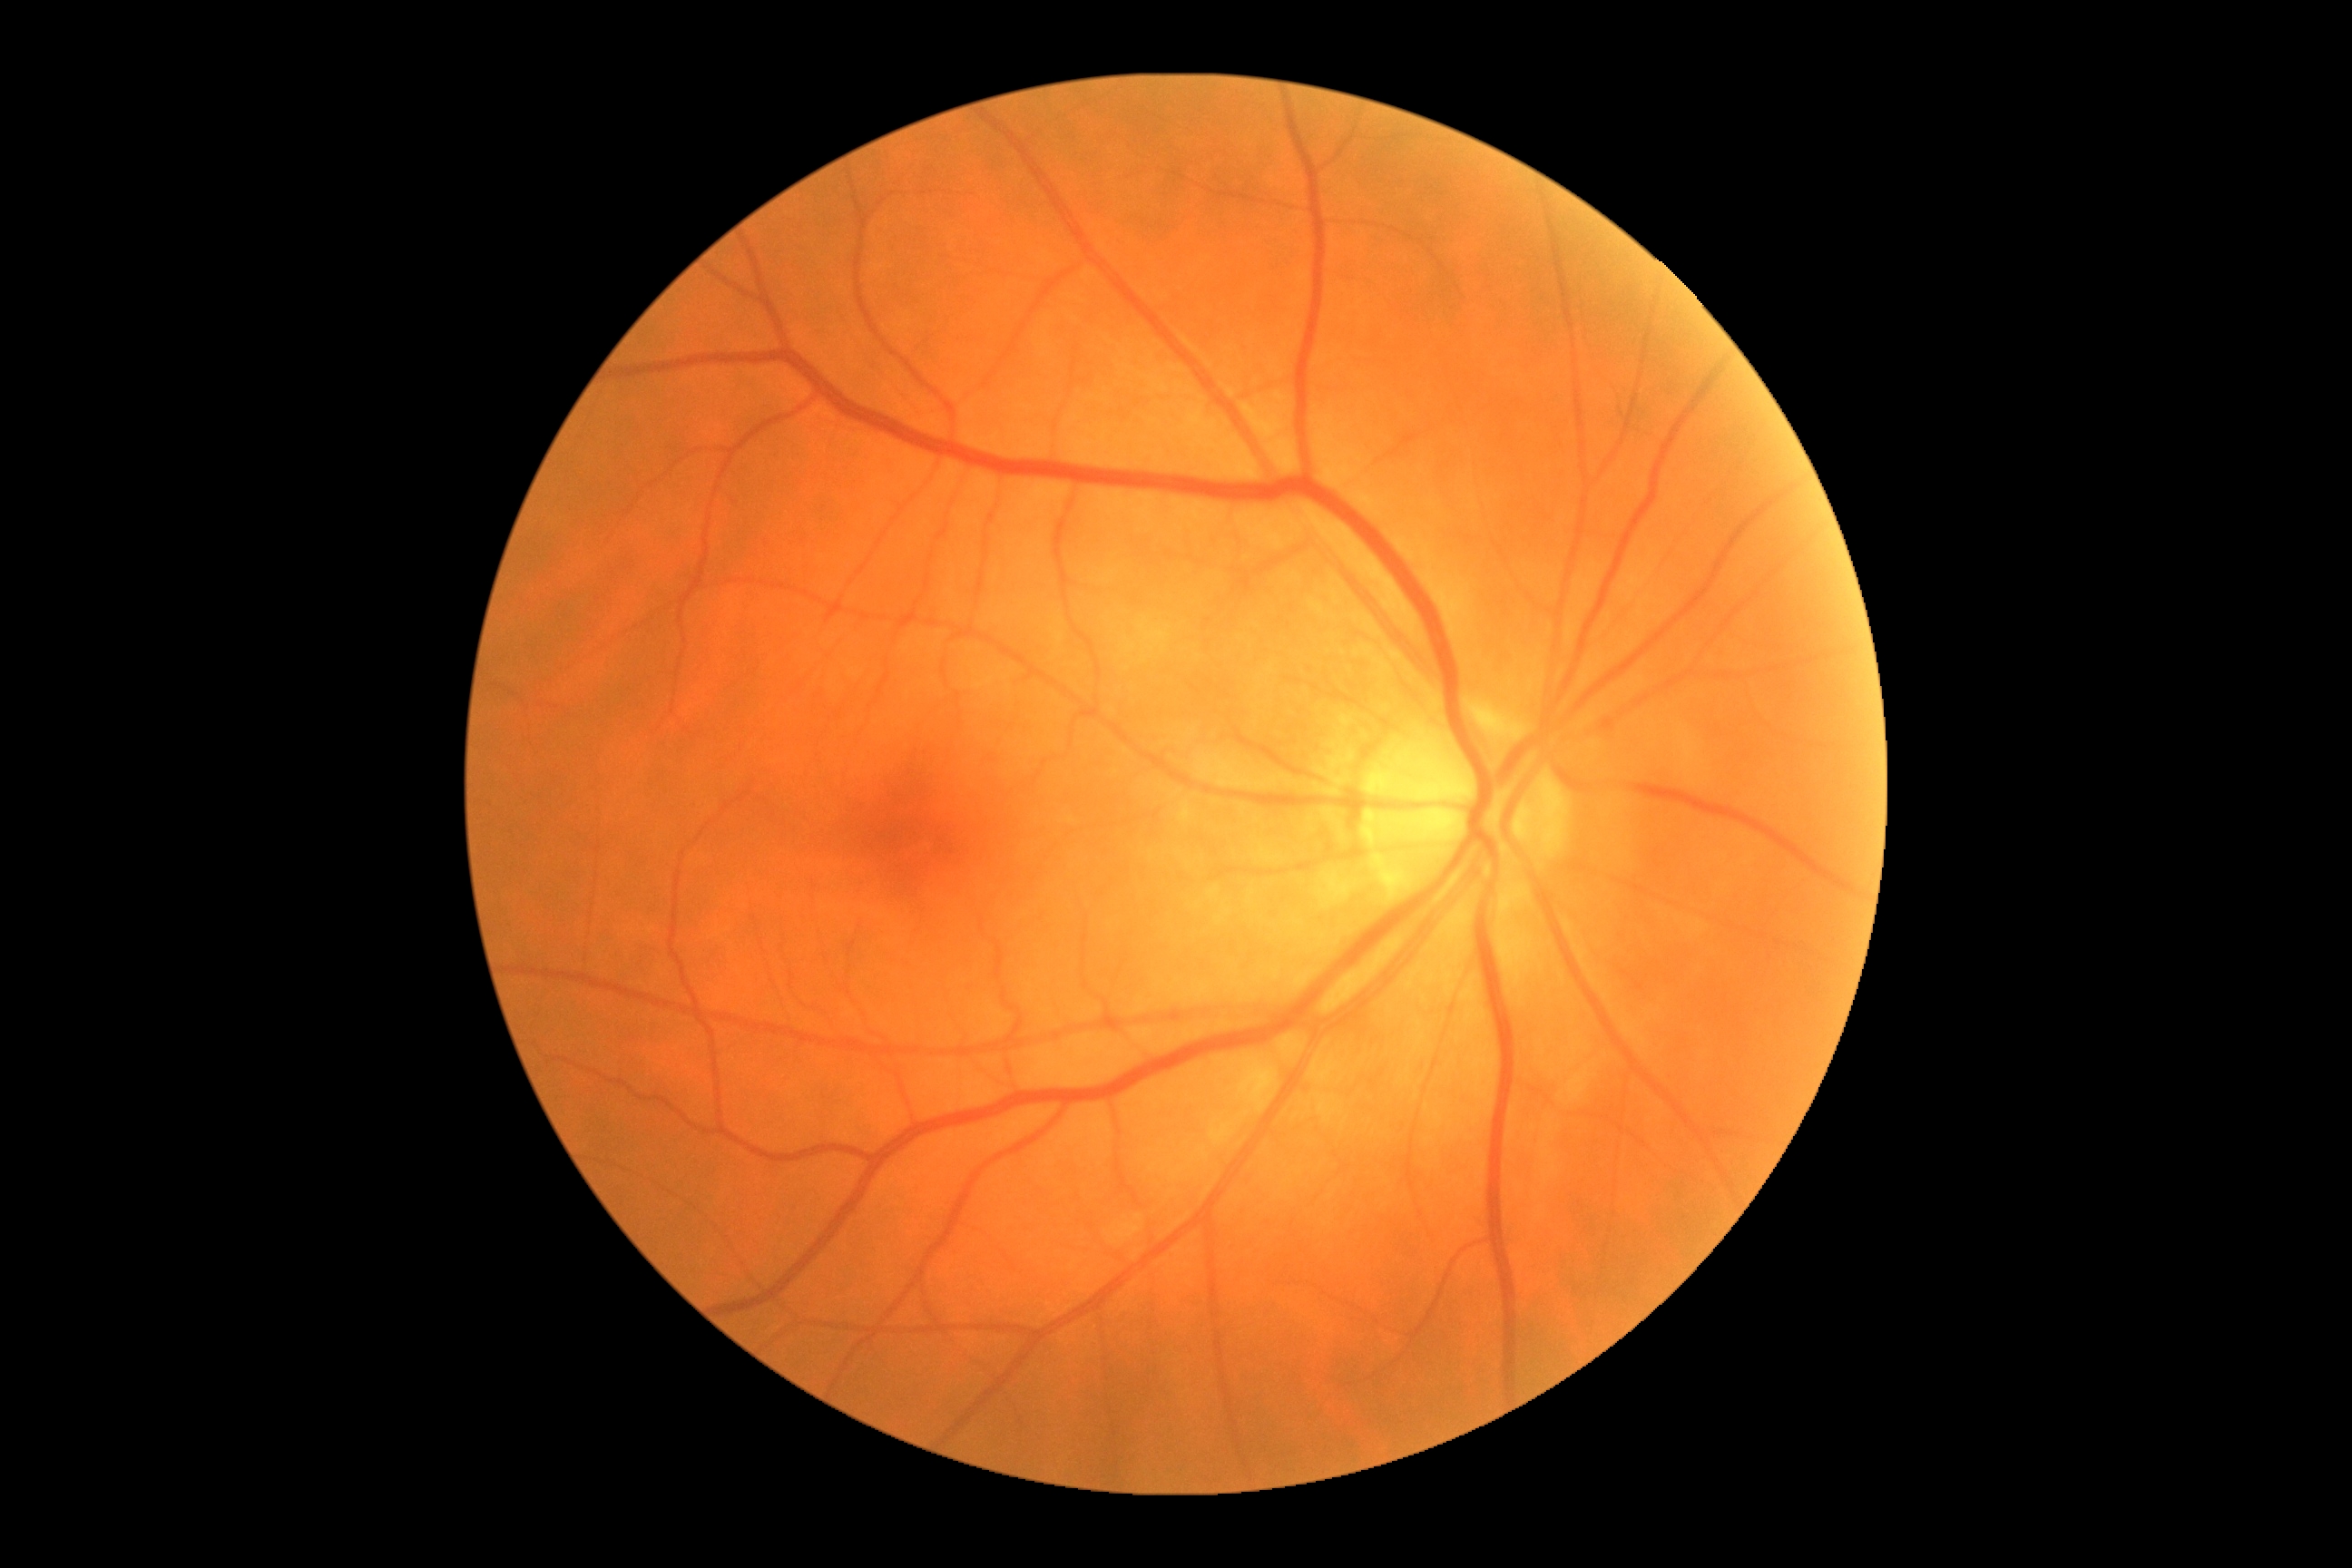

diabetic retinopathy grade: 0/4
DR impression: no signs of DR